Wide-field fundus photograph of an infant:
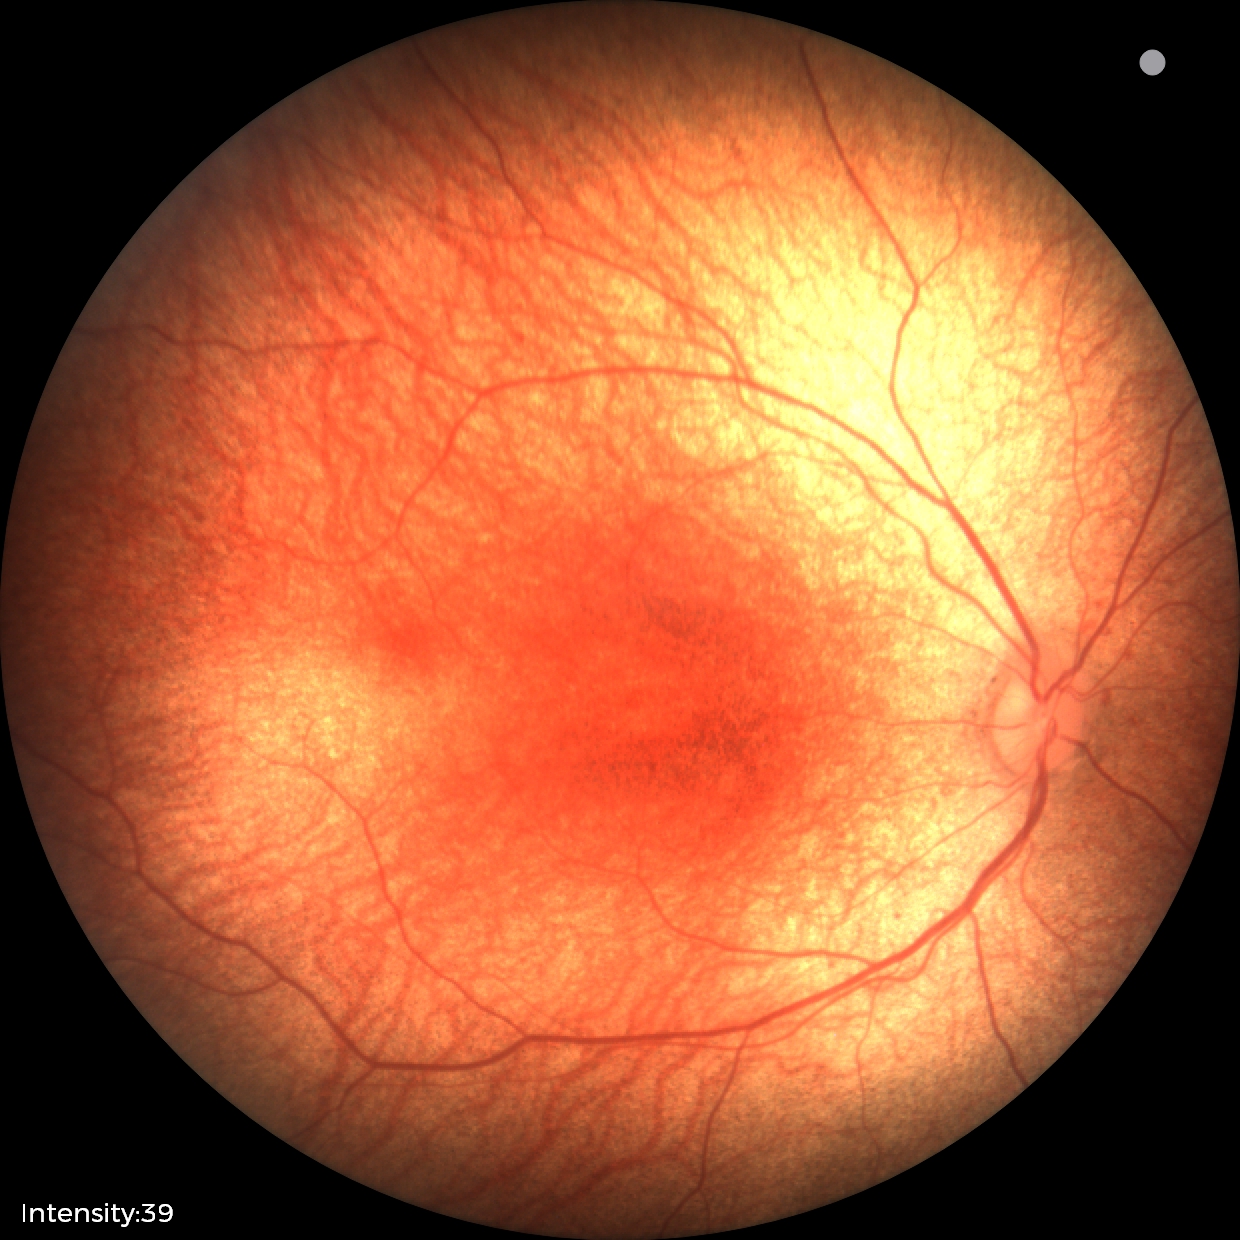 Examination with physiological retinal findings.